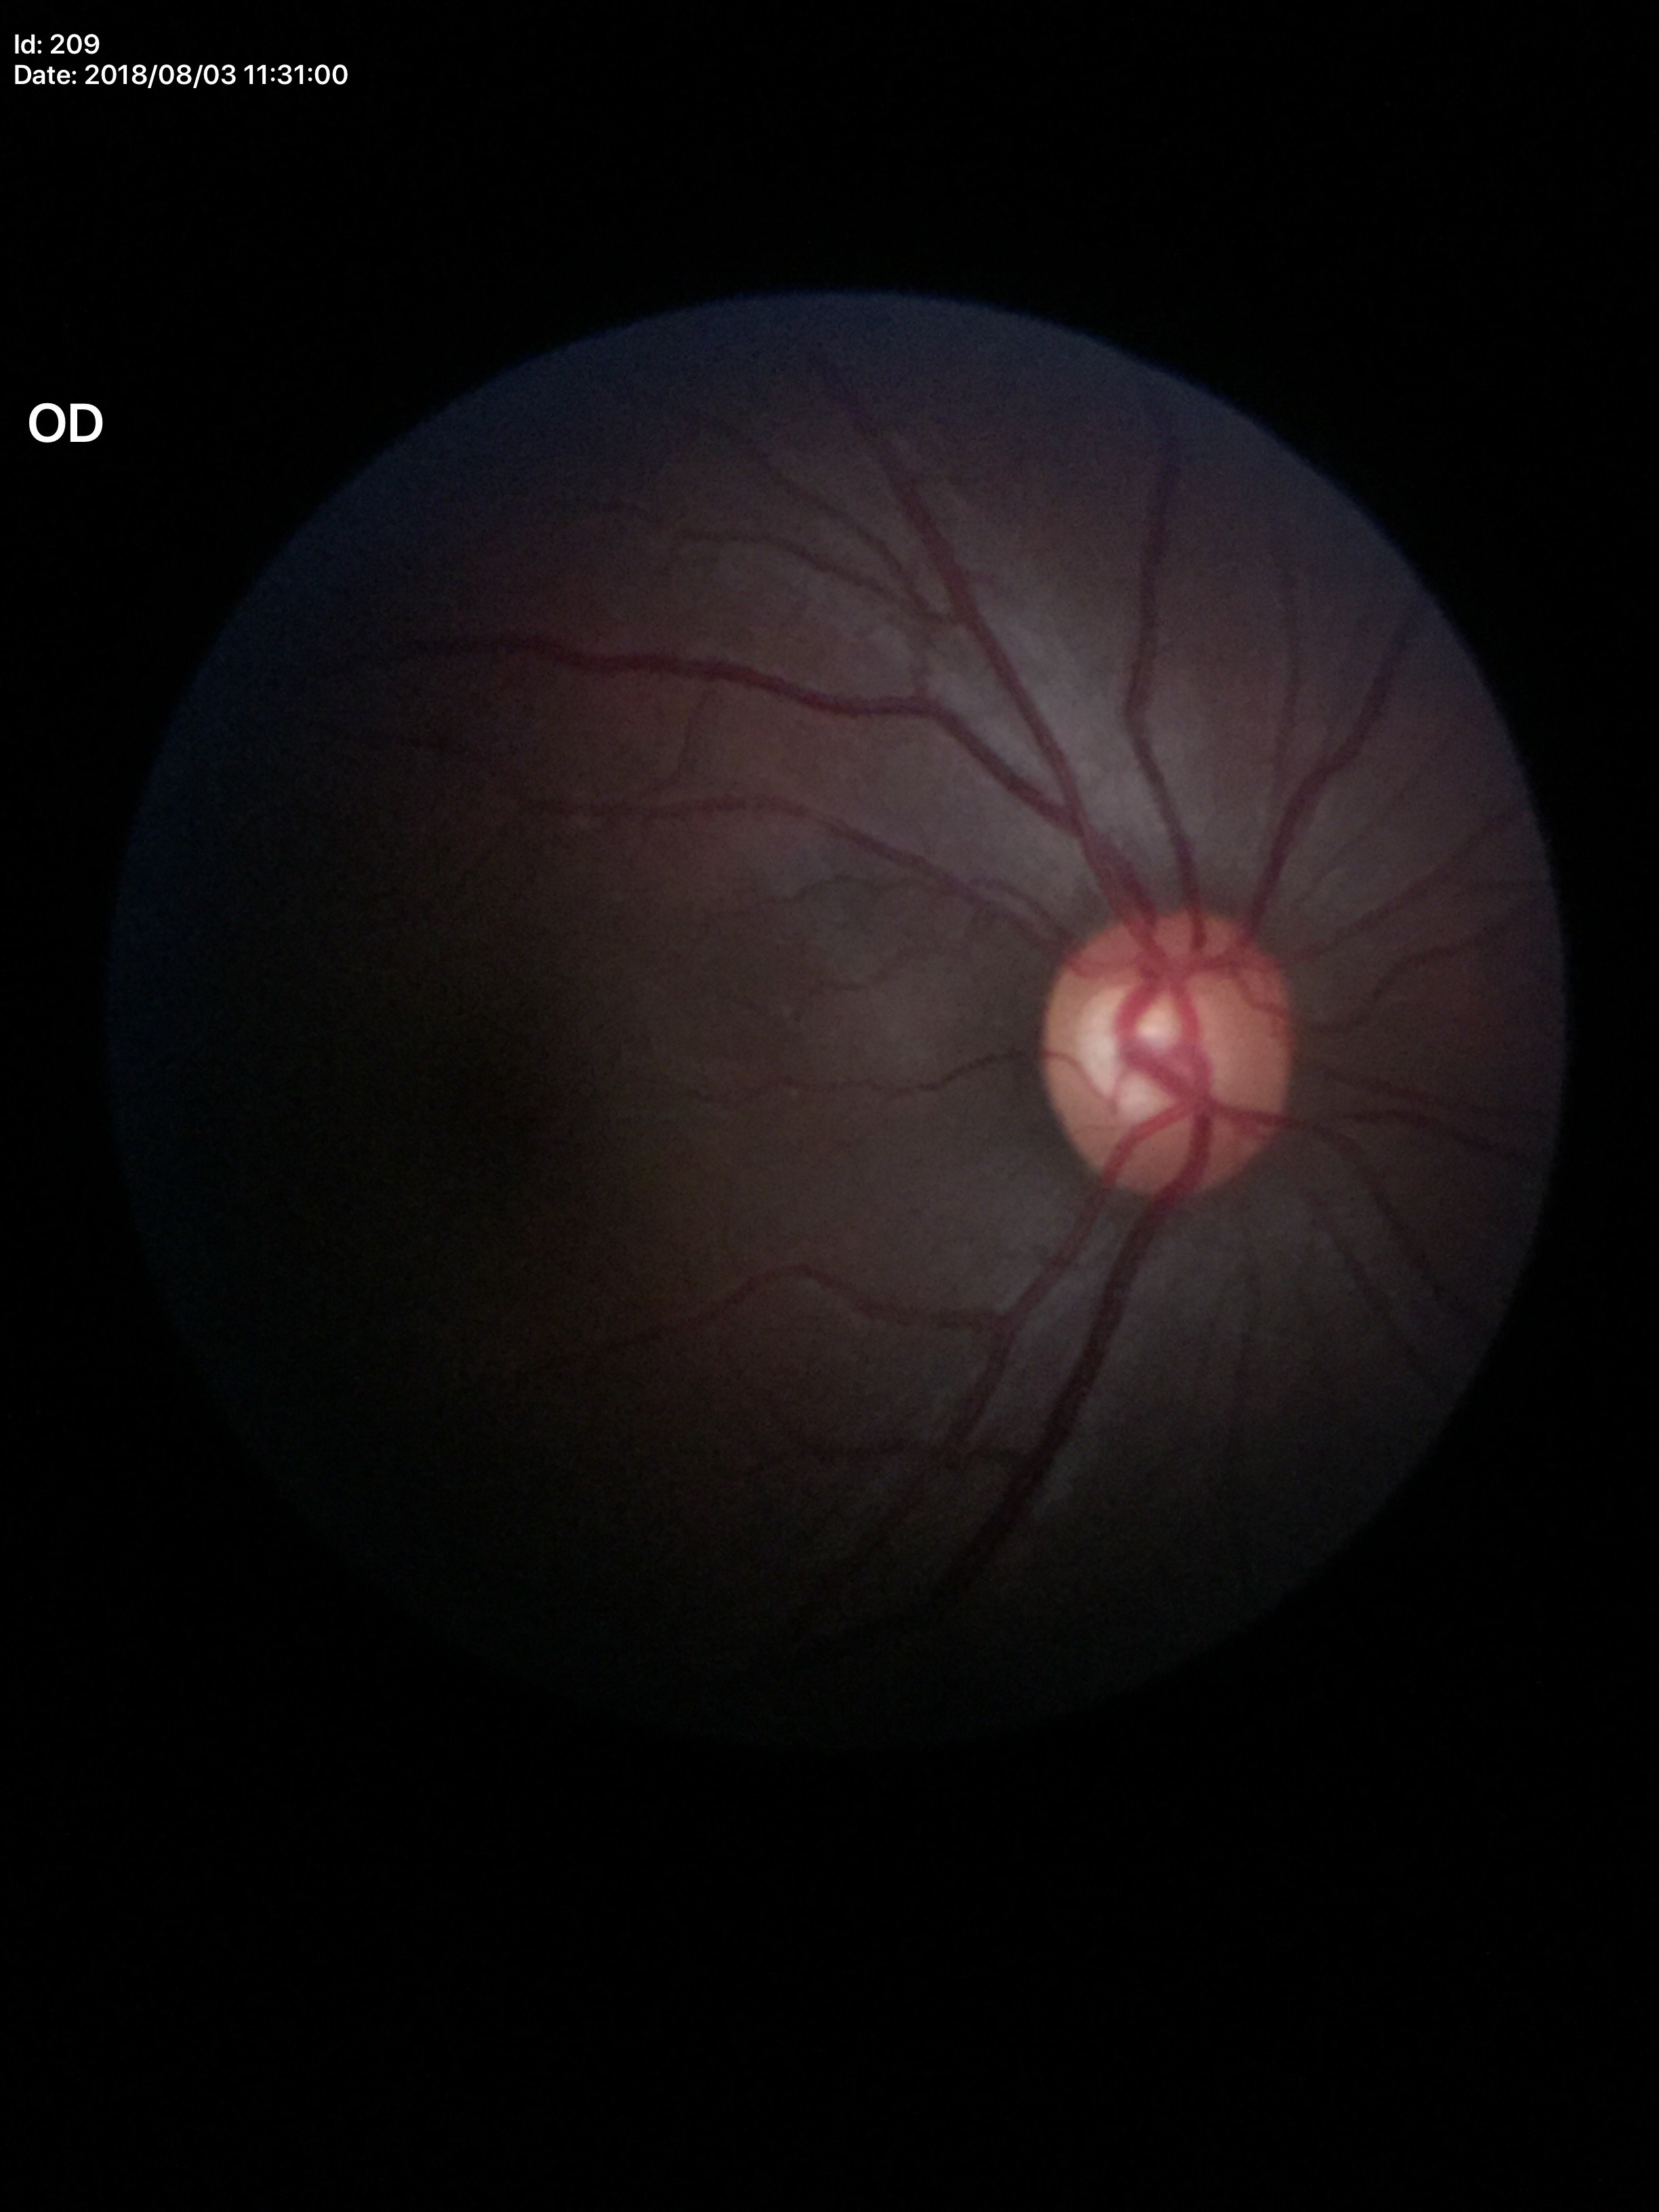

VCDR: 0.54.
HCDR: 0.59.
No evidence of glaucoma.
ACDR is 0.31.